Infant wide-field fundus photograph:
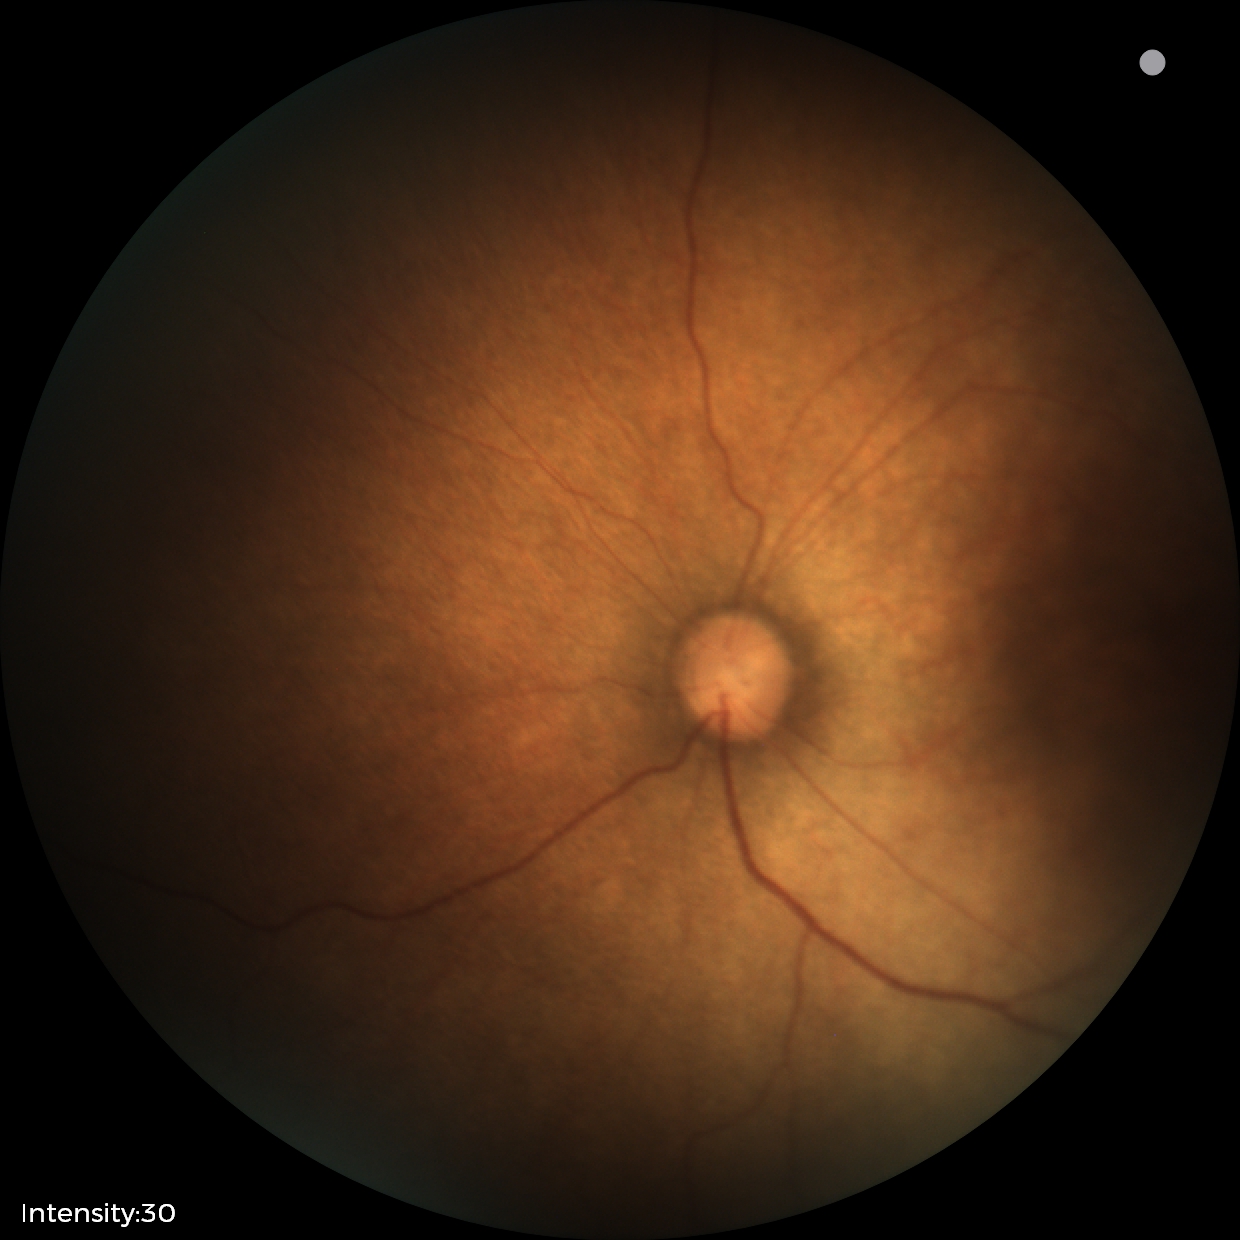
Impression: normal.